Posterior pole view — 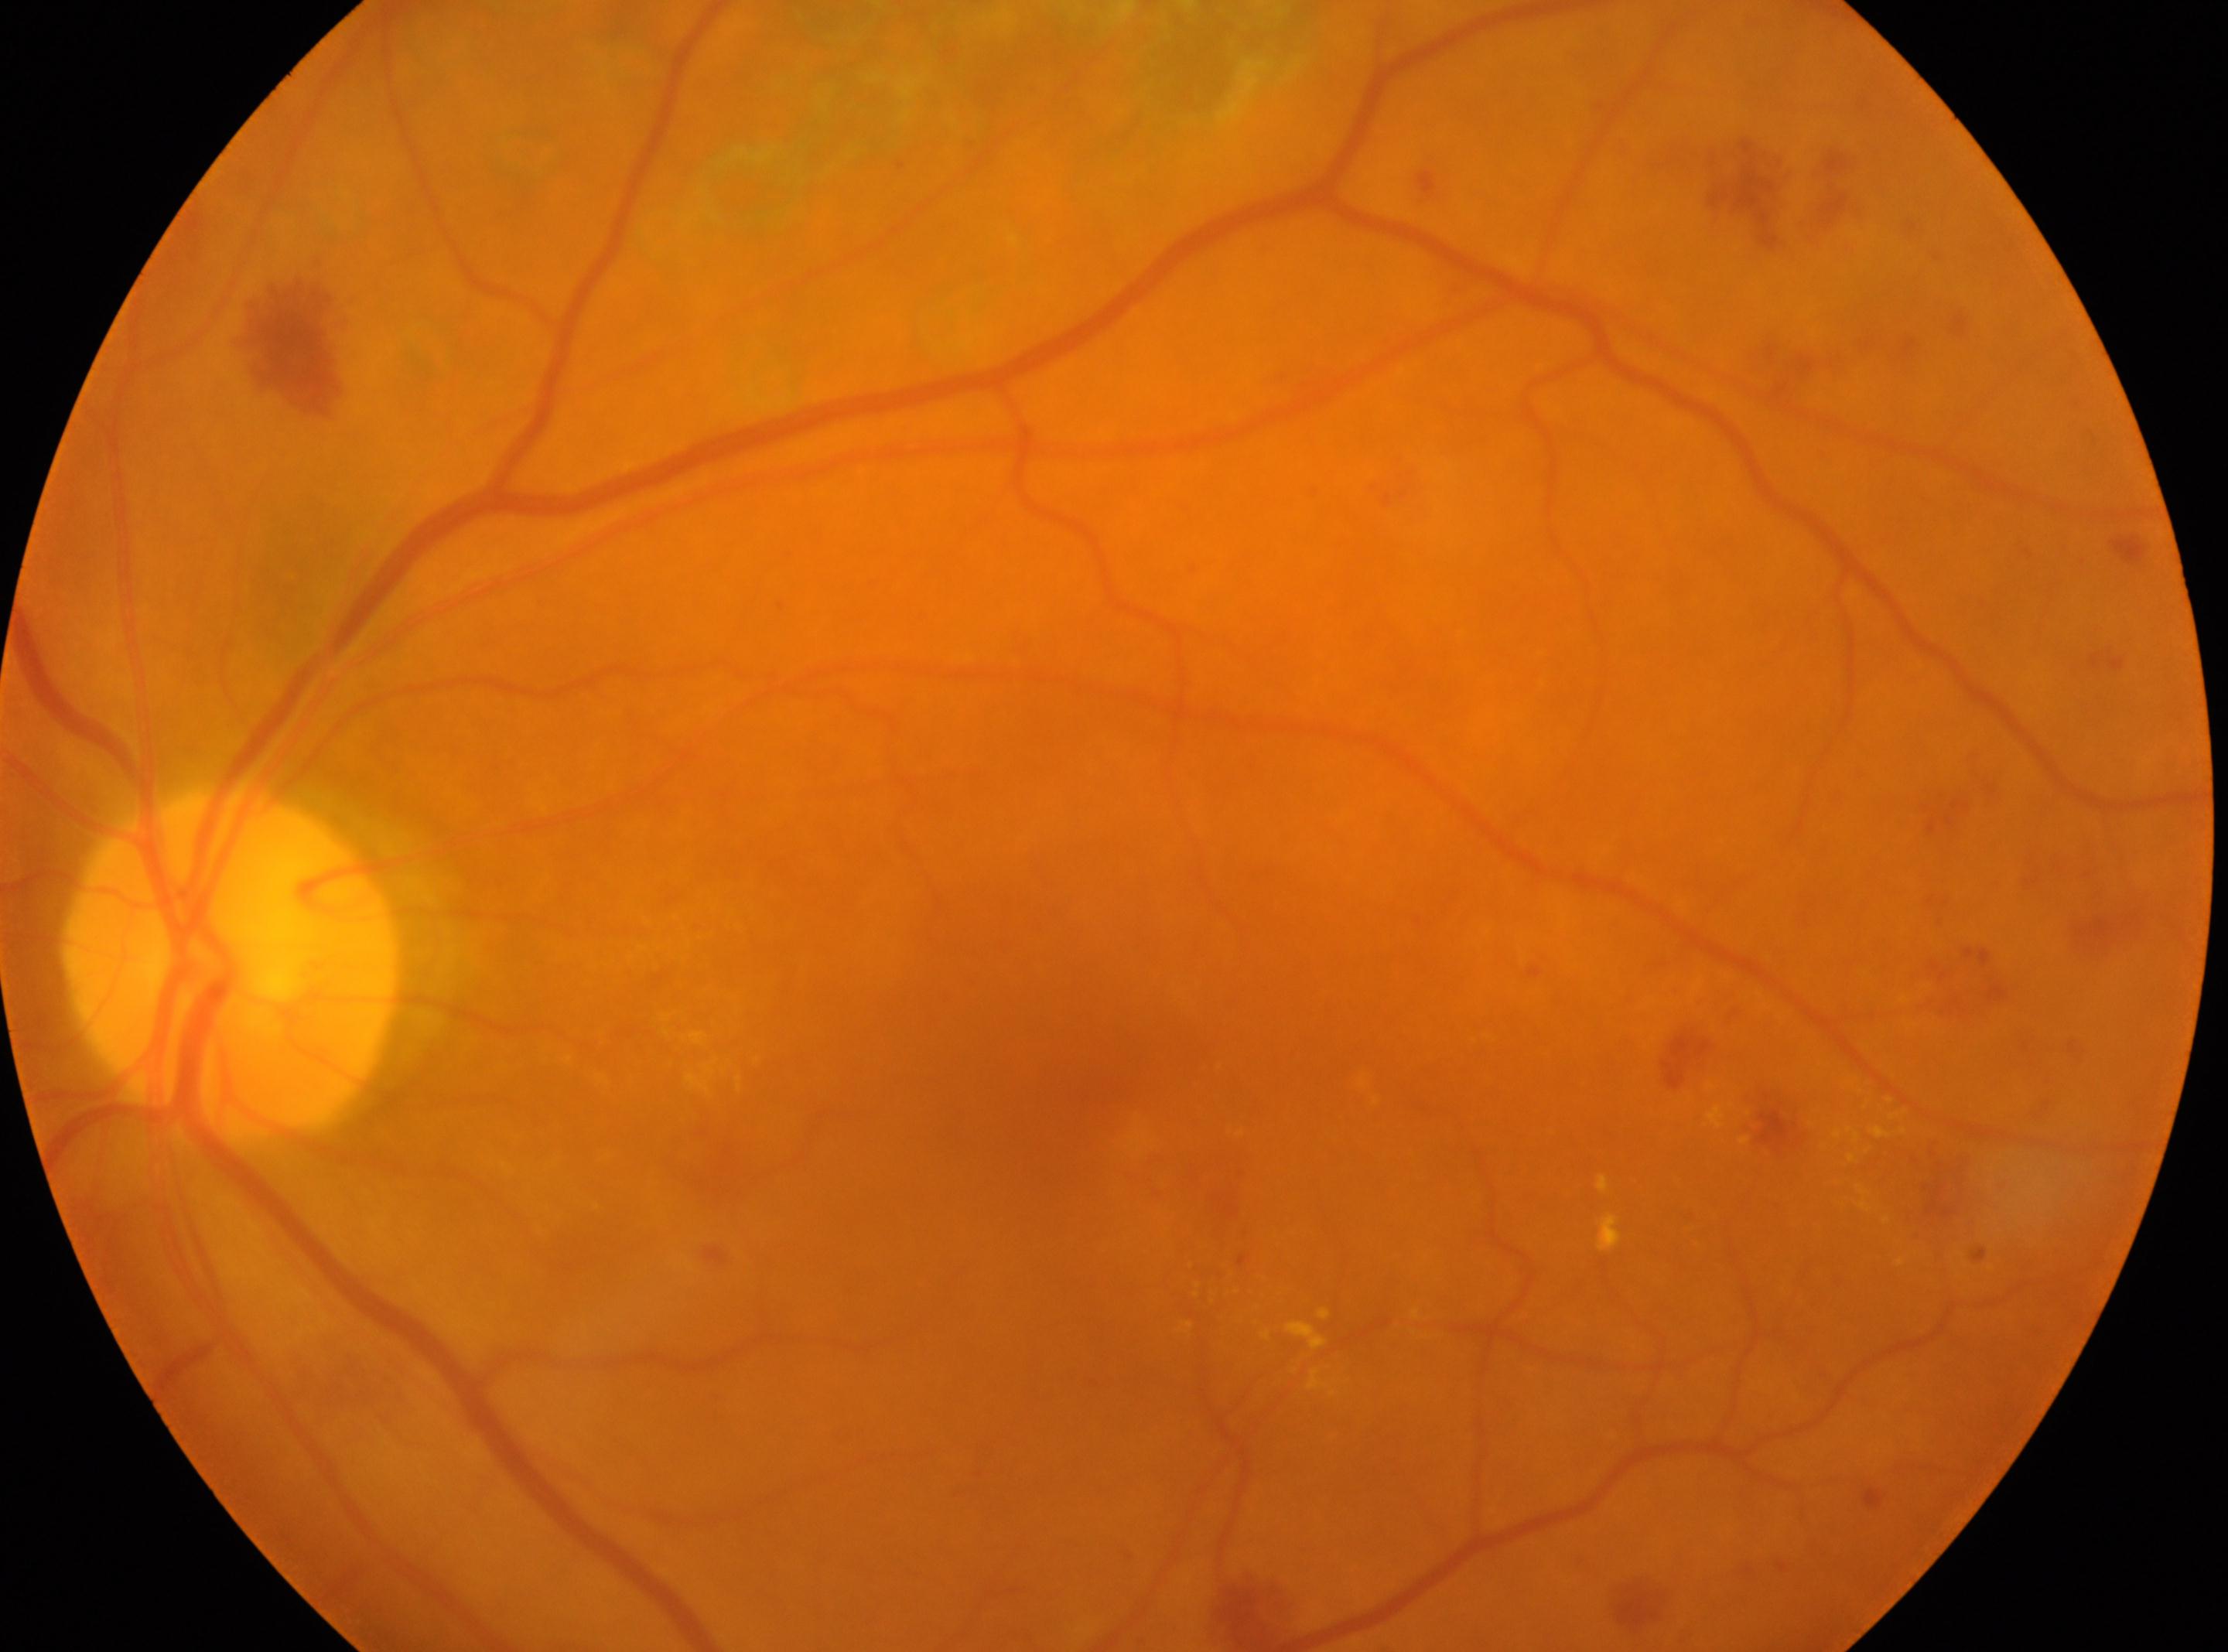 | field | value |
|---|---|
| optic nerve head | (232,964) |
| diabetic retinopathy | DR with laser photocoagulation scars, underlying severity grade 2 (moderate NPDR) |
| macular center | (1085,1084) |
| laterality | the left eye |